Retinal fundus photograph.
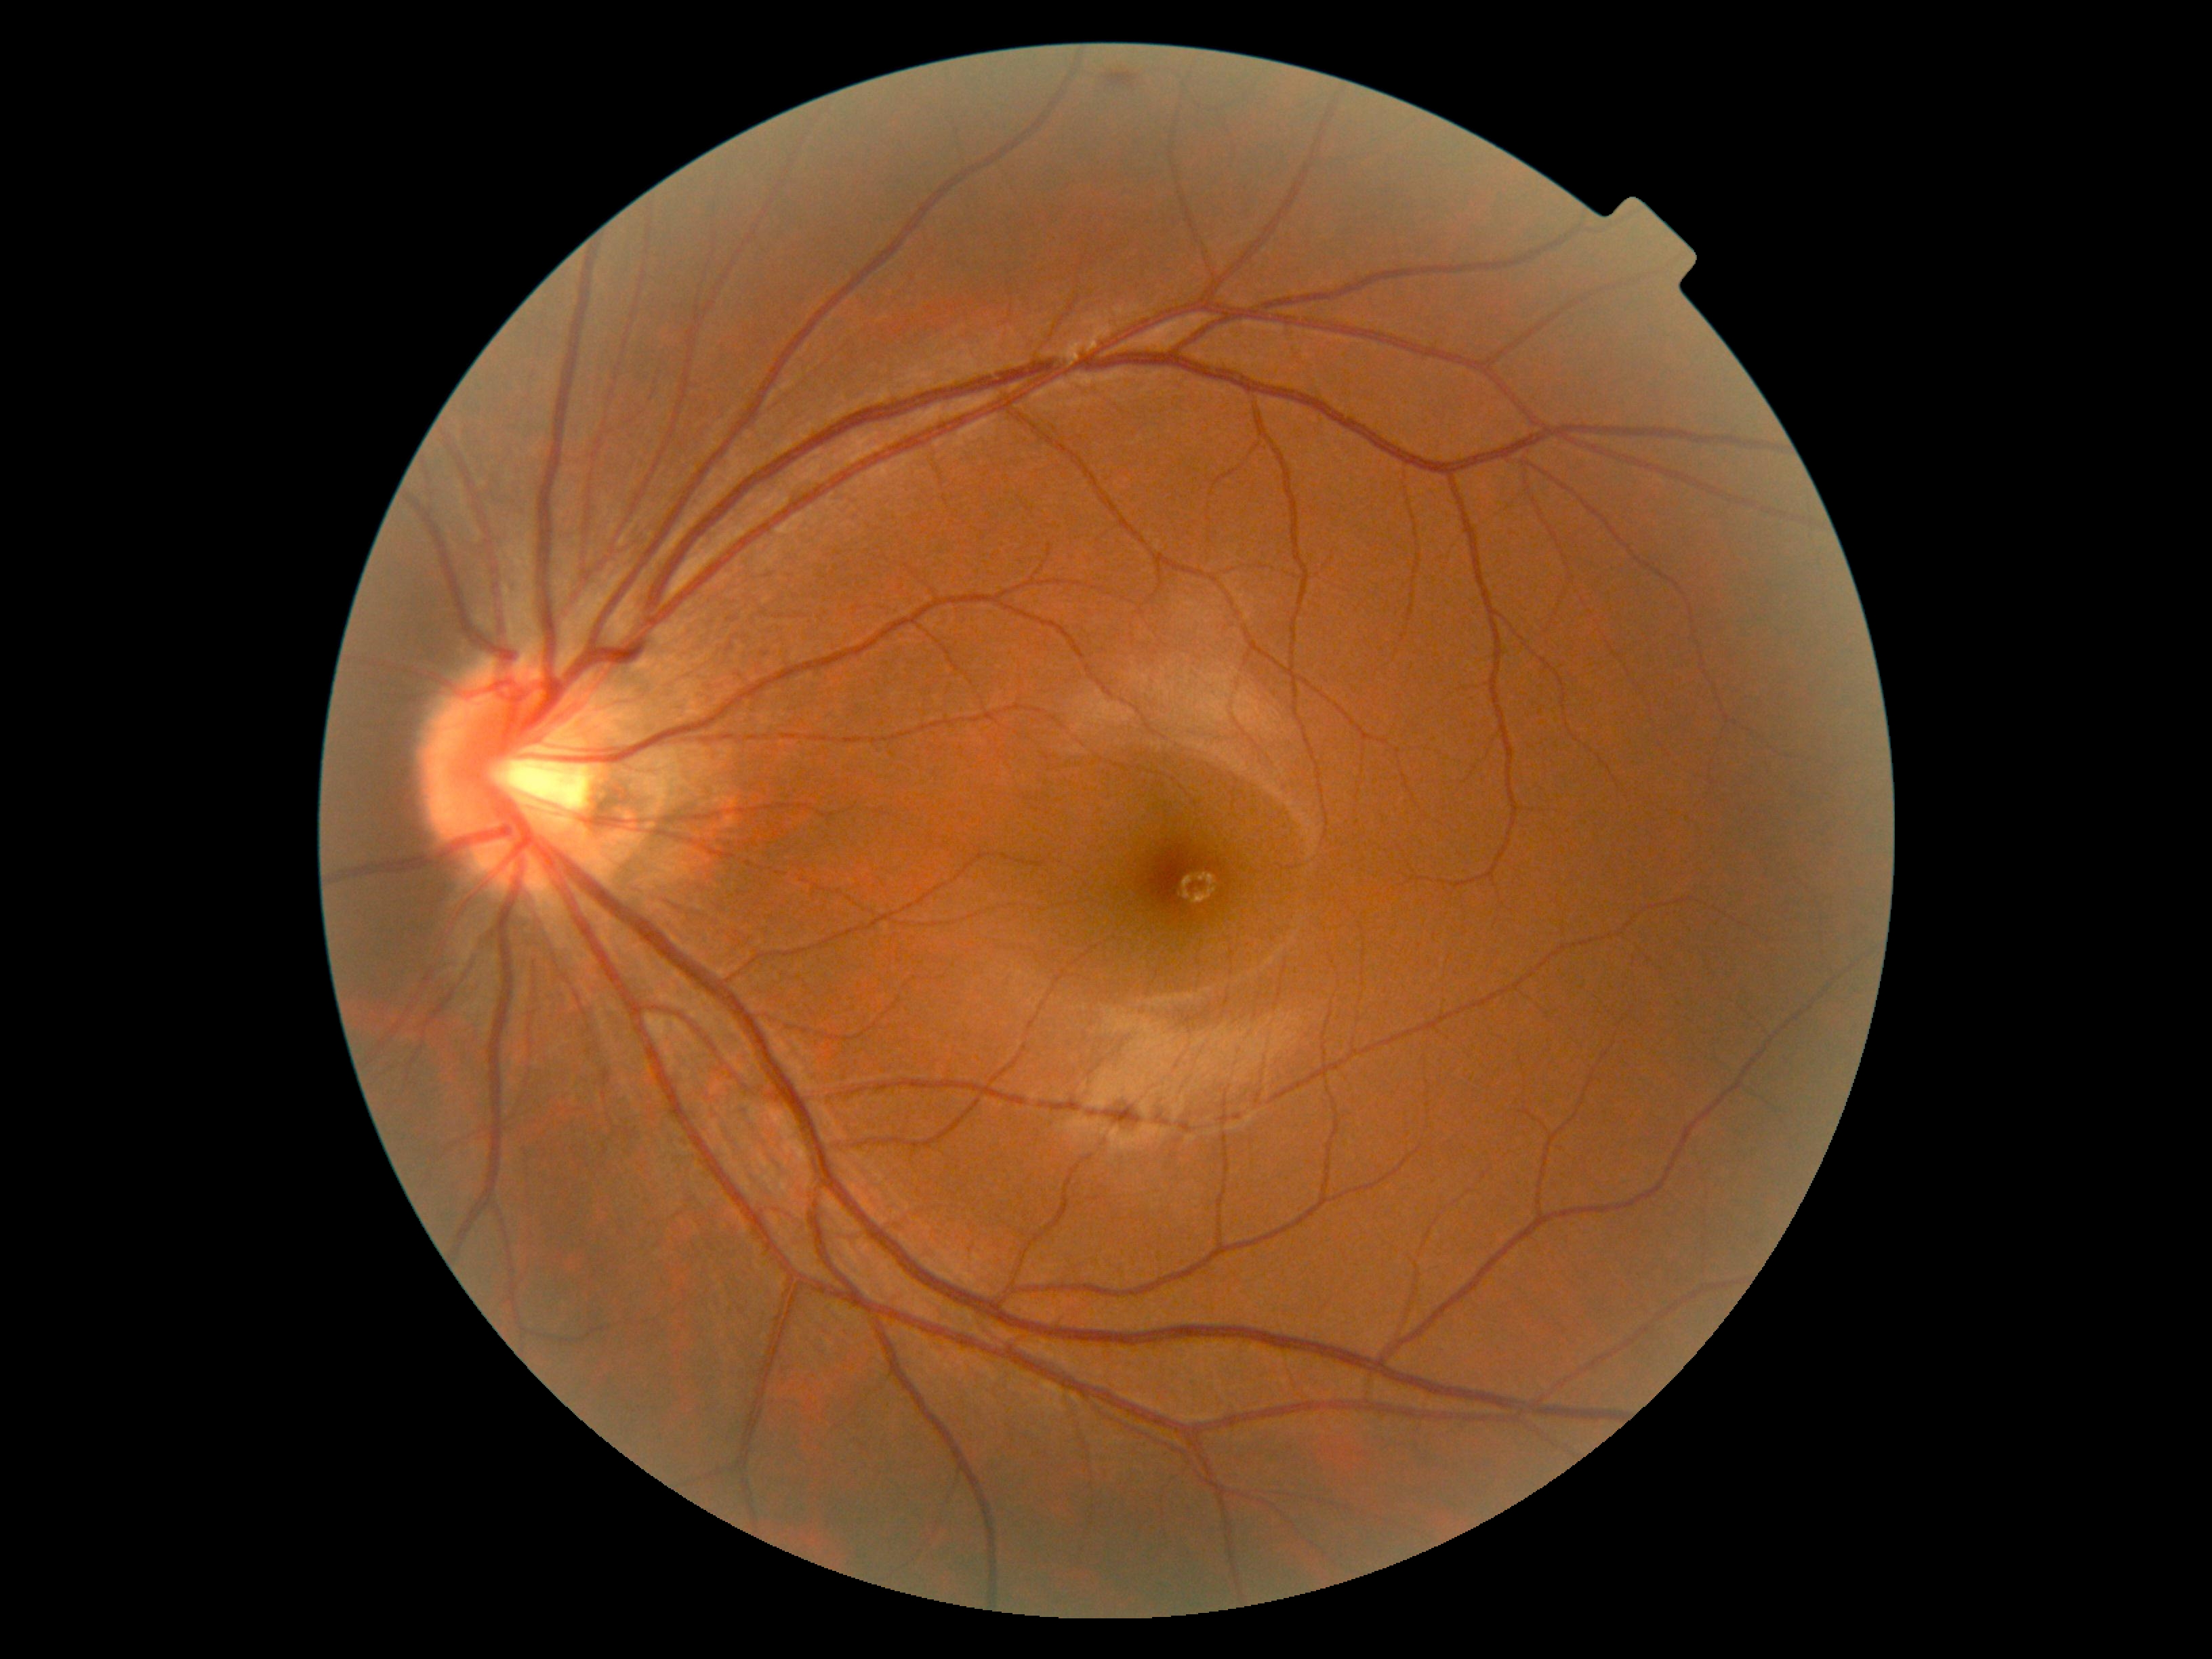
diabetic retinopathy (DR) = no apparent diabetic retinopathy (grade 0).